Graded on the modified Davis scale · 45° field of view:
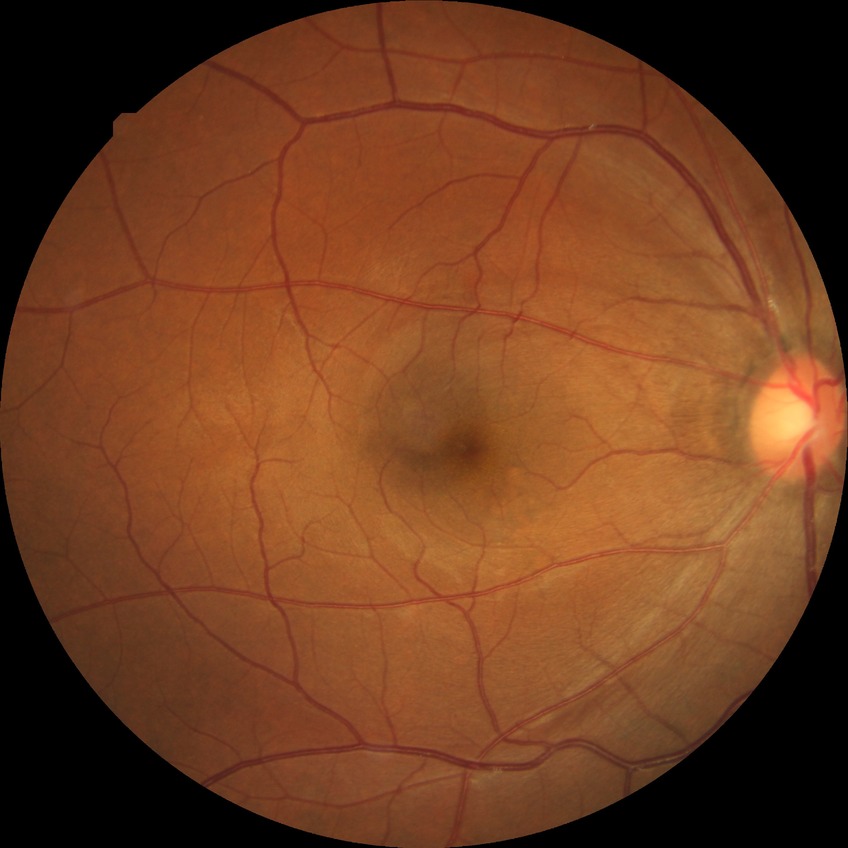
Retinopathy grade is no diabetic retinopathy.